2352 by 1568 pixels: 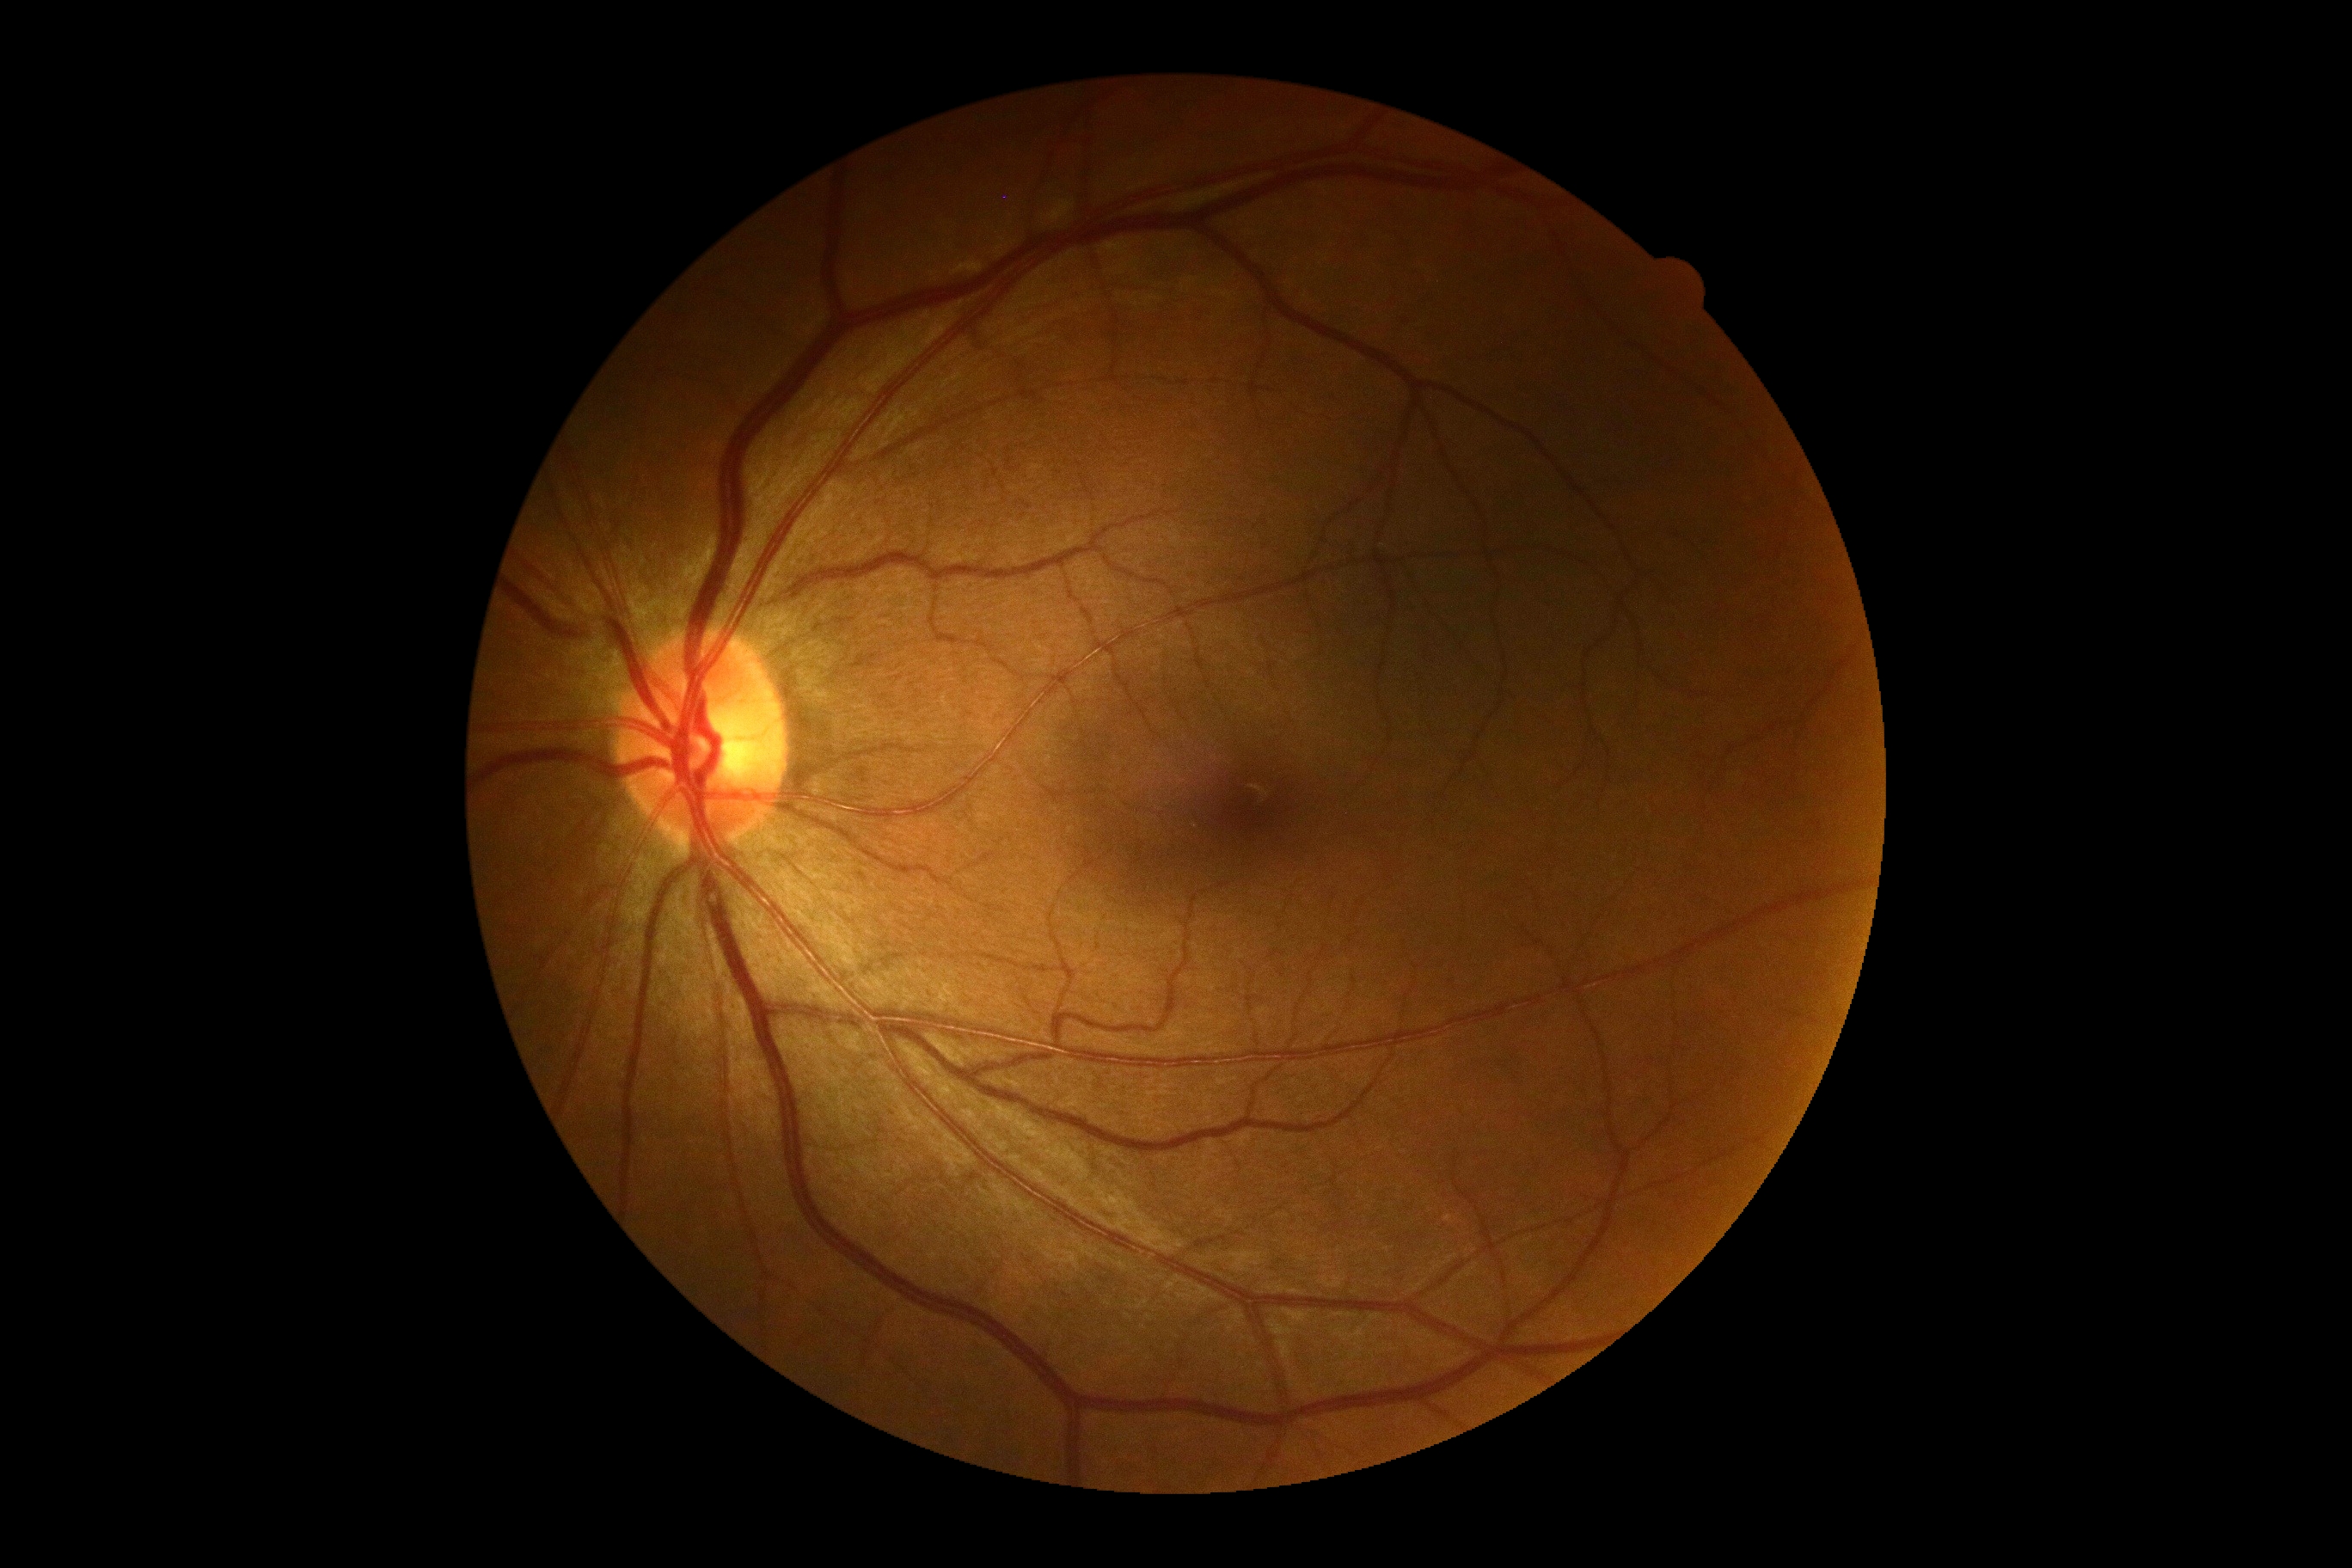

No DR findings. DR stage is 0.